848x848 — 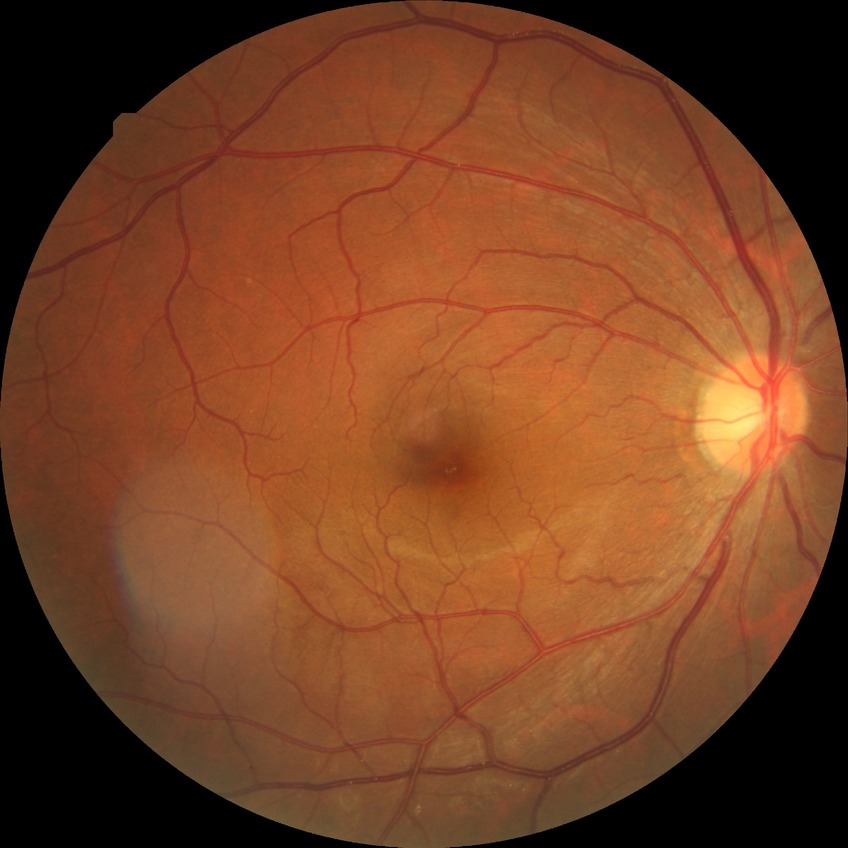 Davis stage: NDR.